45-degree field of view · 2048 x 1536 pixels · retinal fundus photograph.
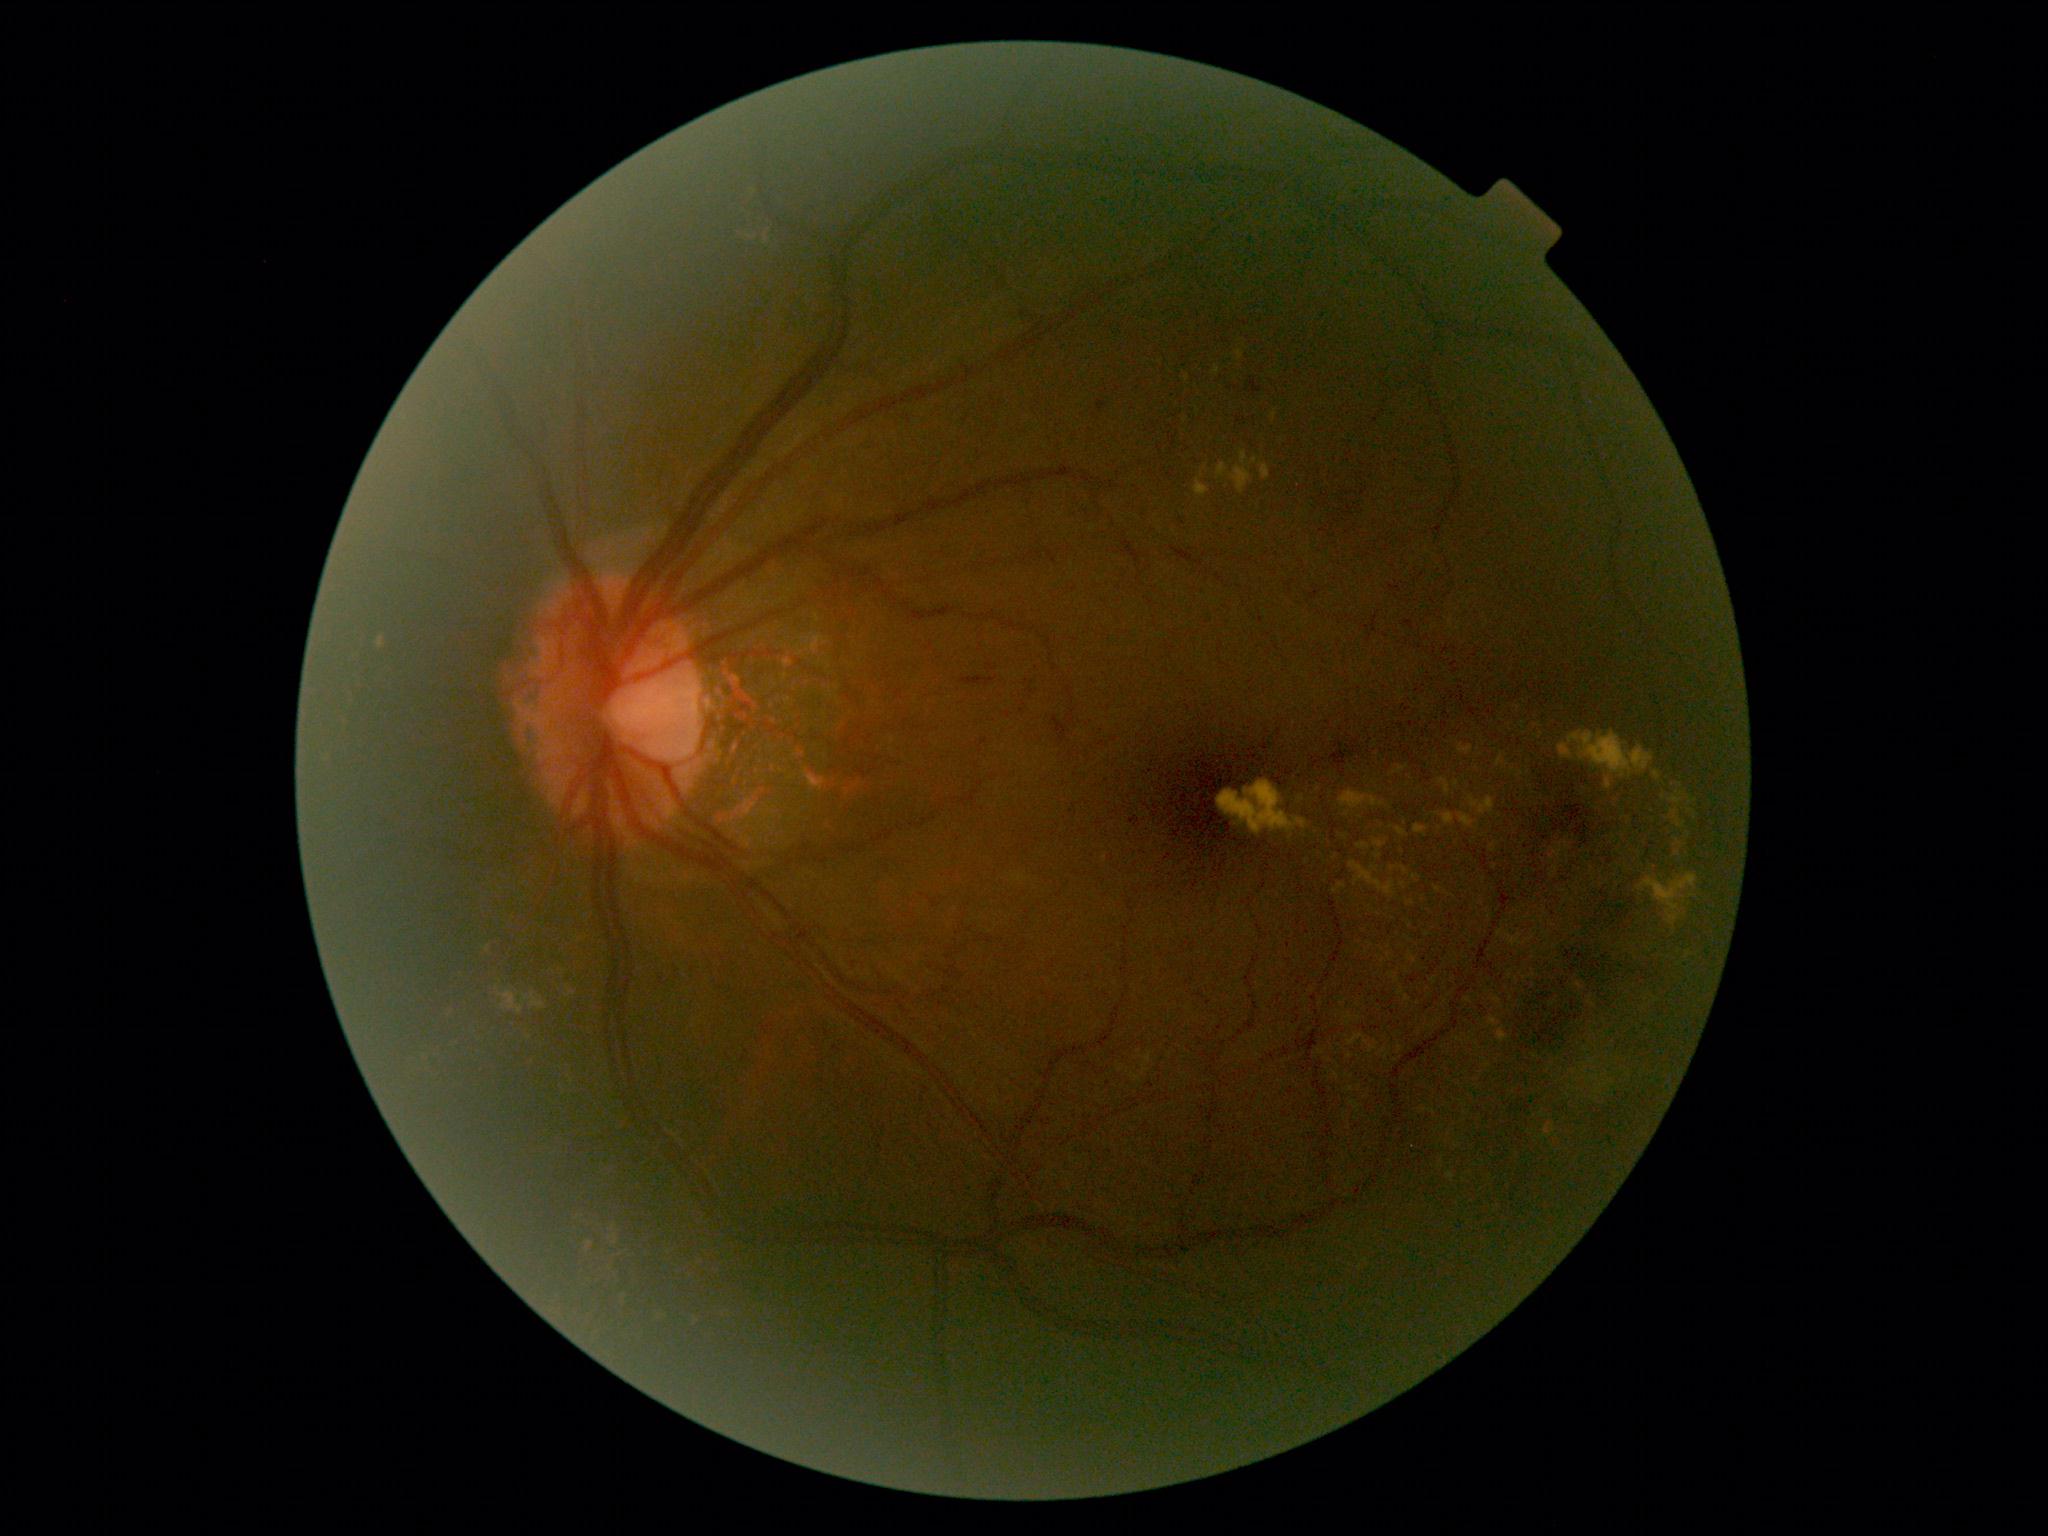
Diabetic retinopathy (DR): moderate non-proliferative diabetic retinopathy (grade 2) — more than just microaneurysms but less than severe NPDR.